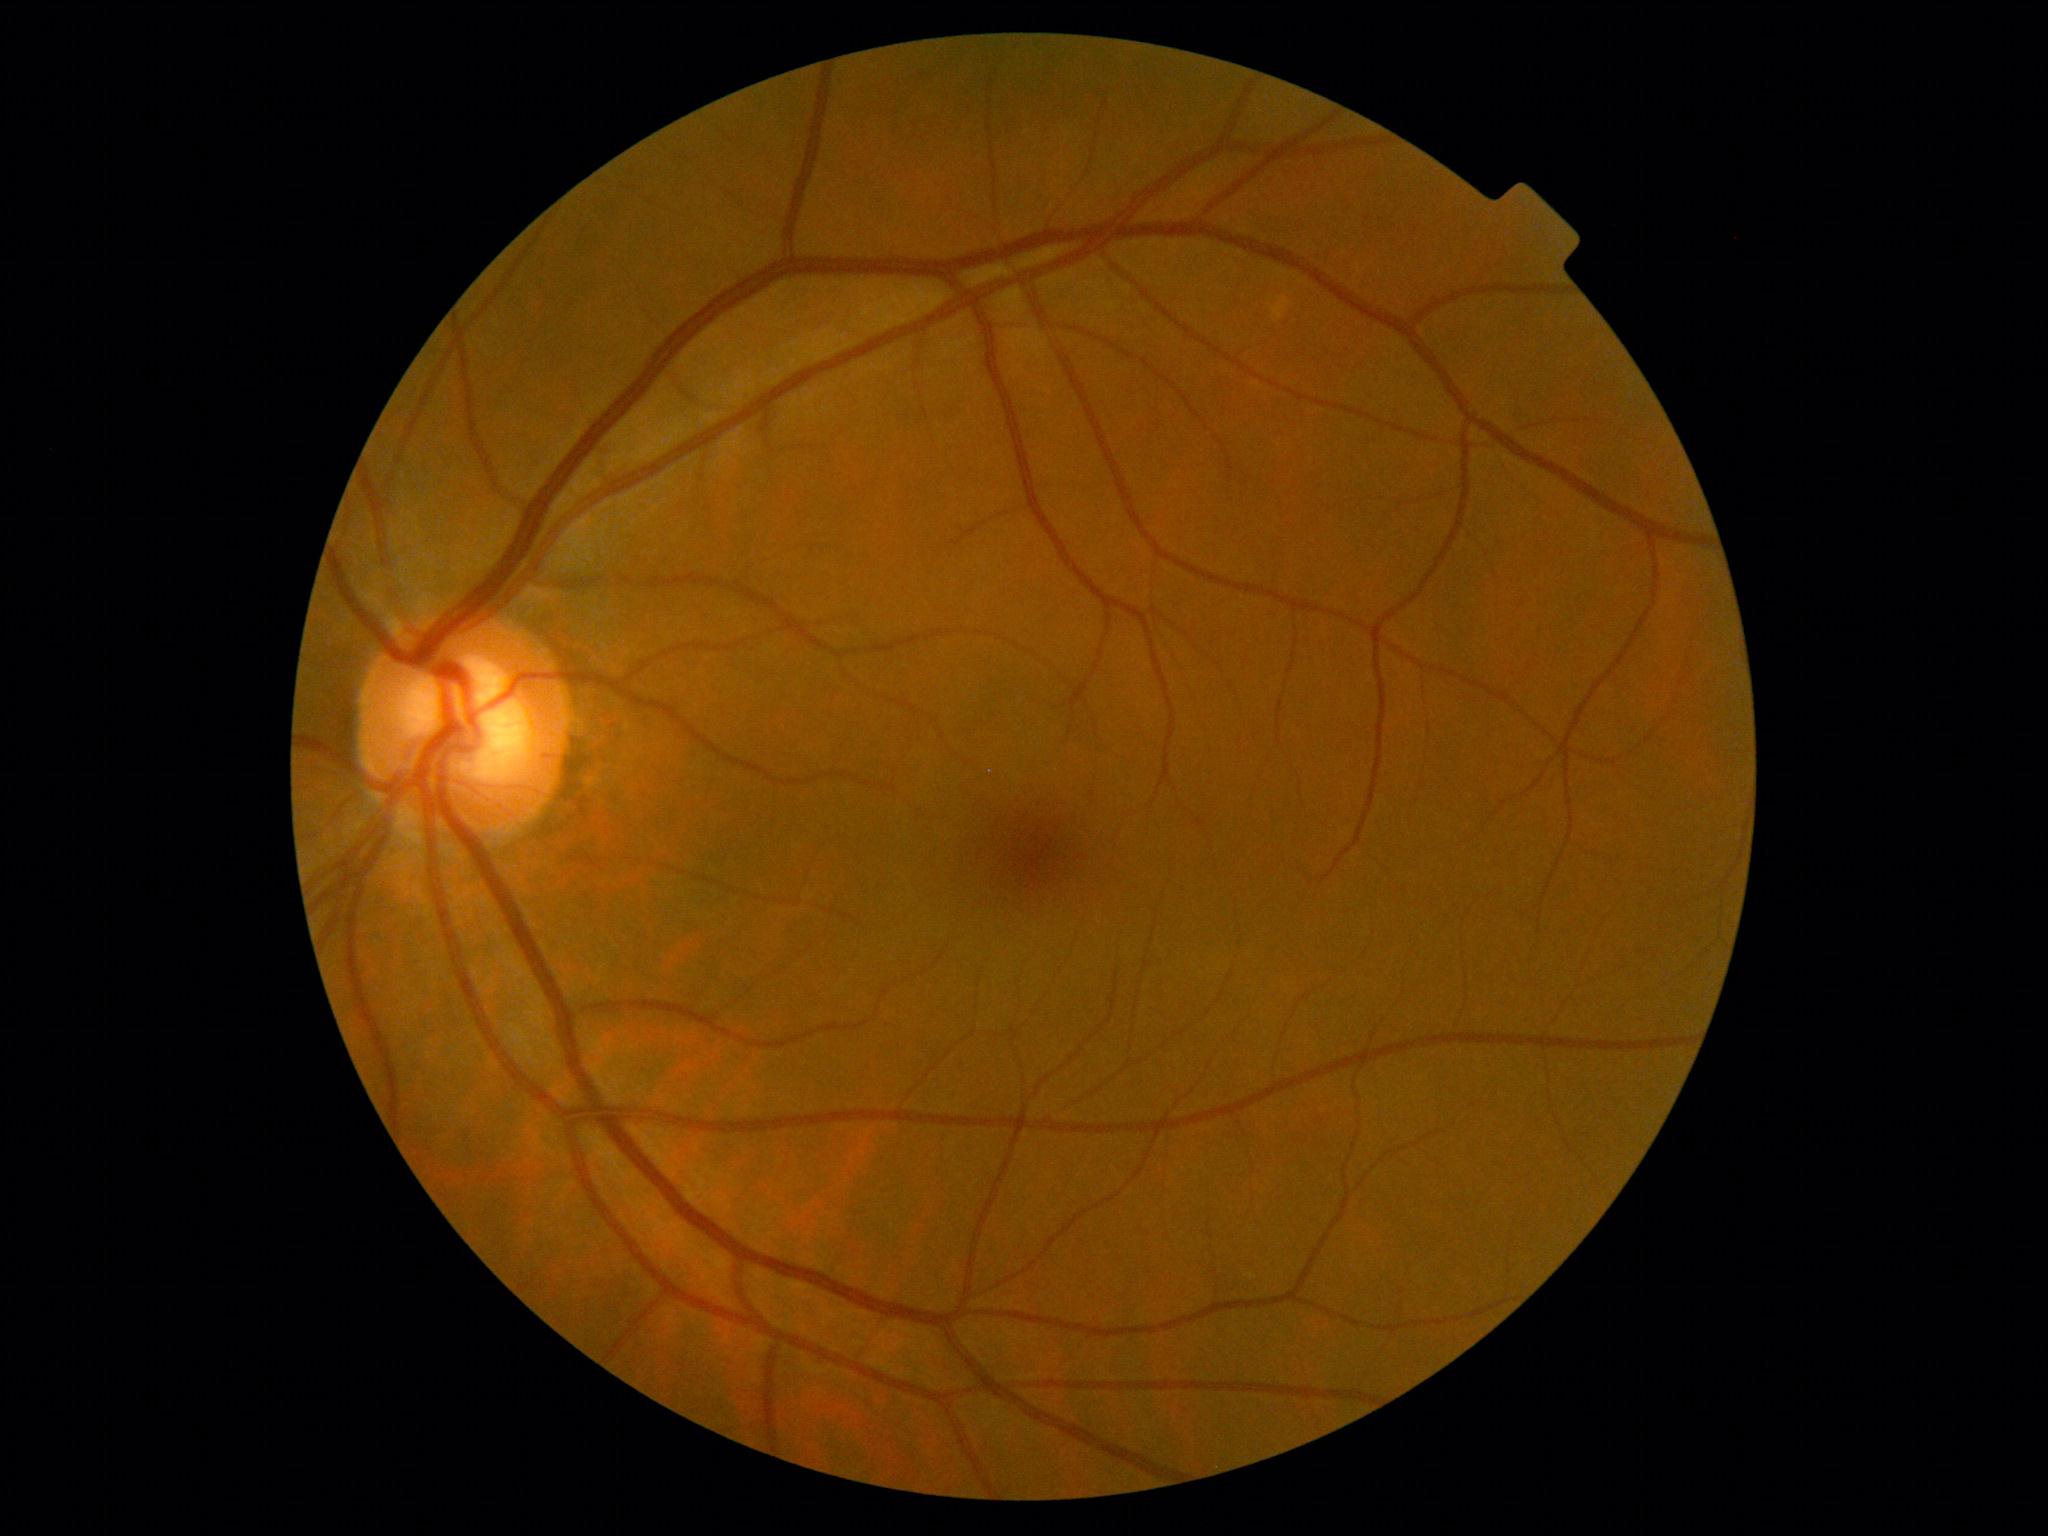

DR grade: 0 — no visible signs of diabetic retinopathy.